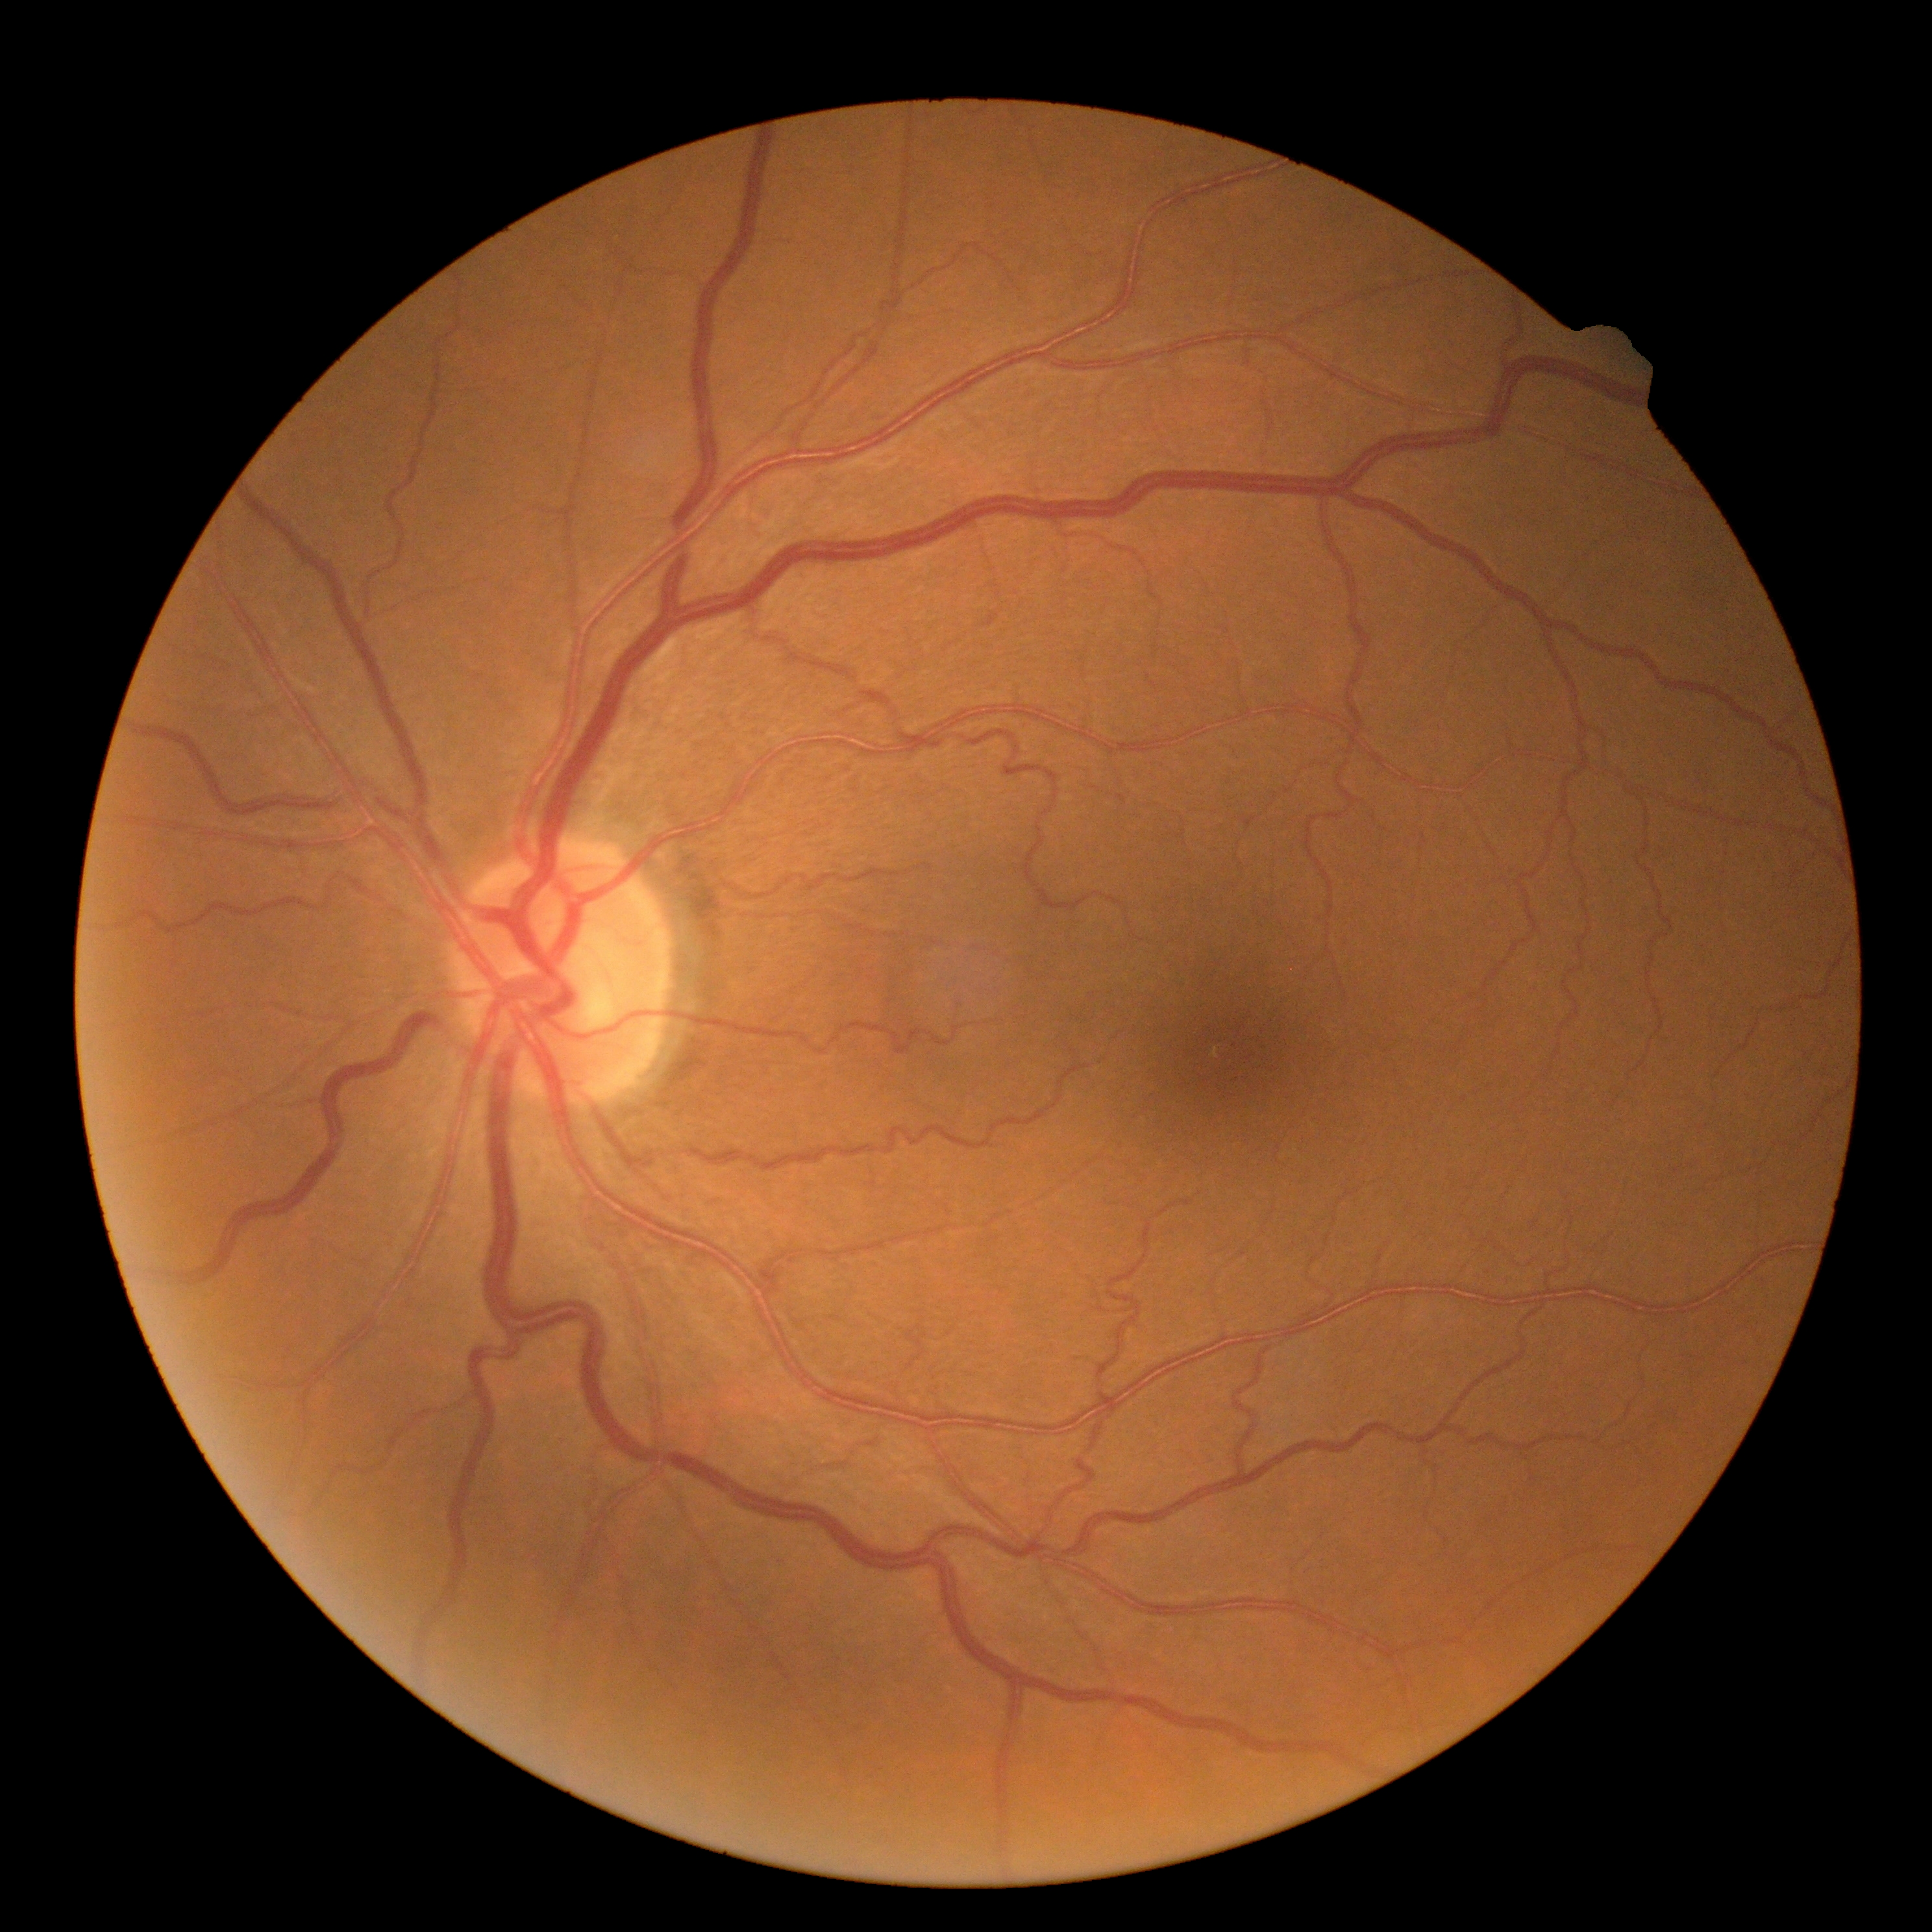 Retinopathy: grade 0.